Pediatric retinal photograph (wide-field)
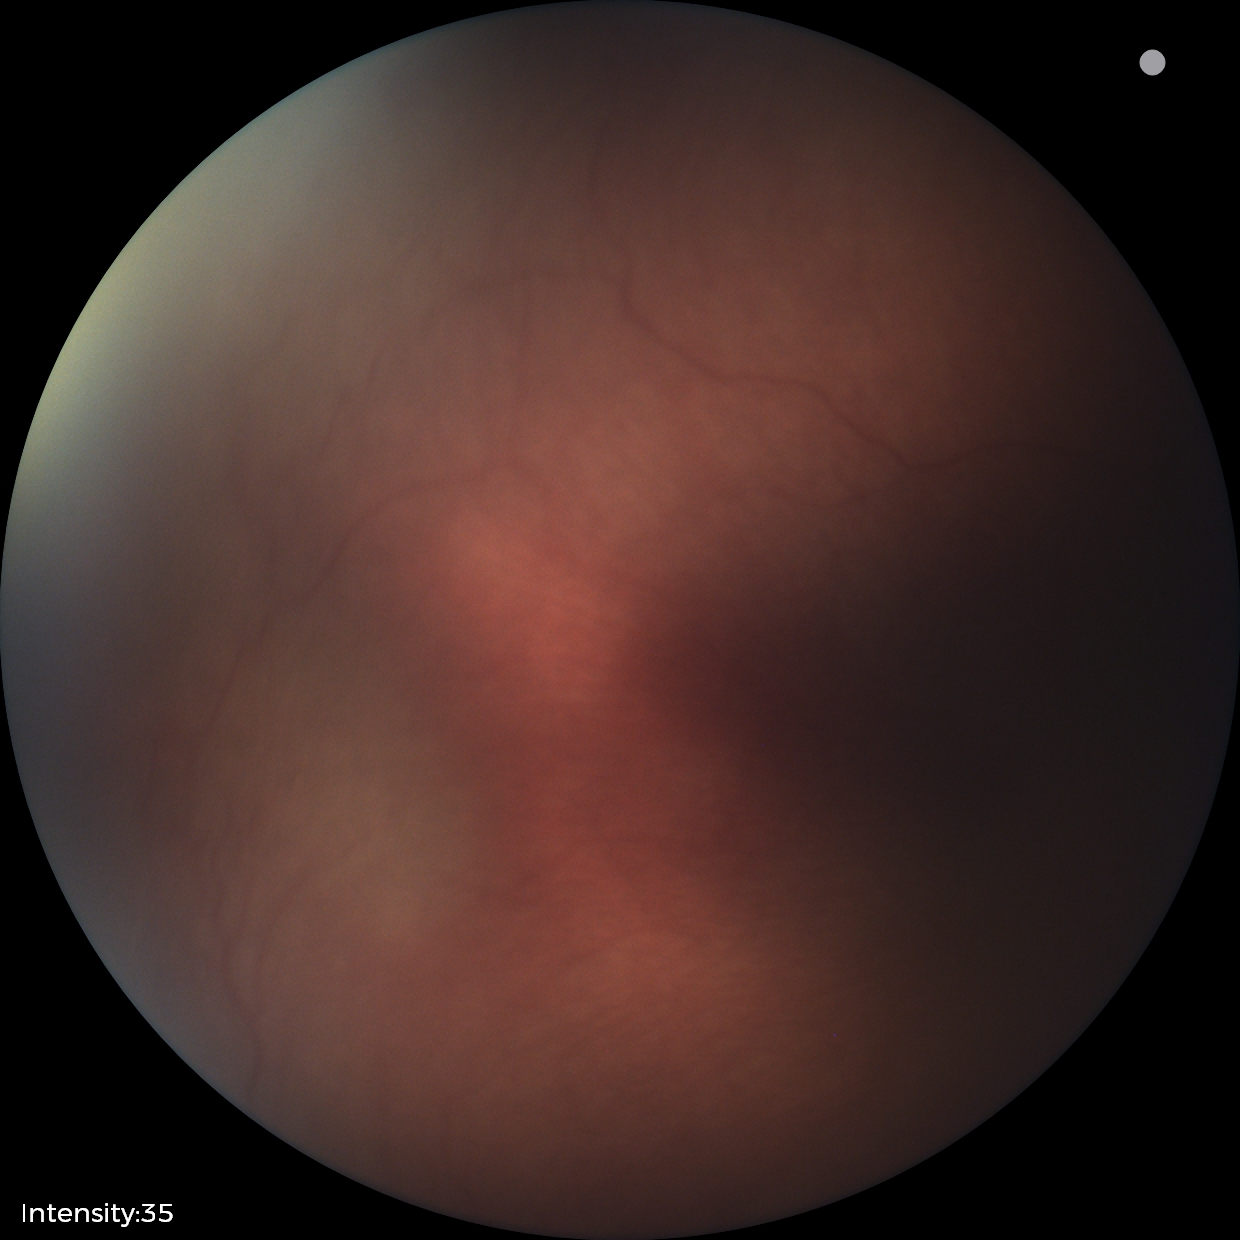
Physiological retinal appearance for postconceptual age.